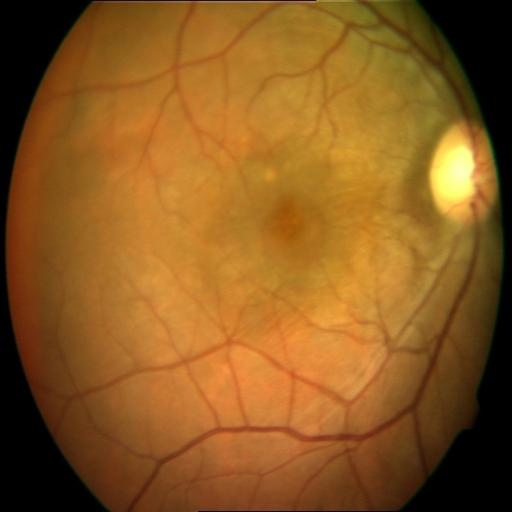
2 abnormalities. Color fundus photograph showing cystoid macular edema (CME) & epiretinal membrane (ERM).